2352 by 1568 pixels. Color fundus photograph — 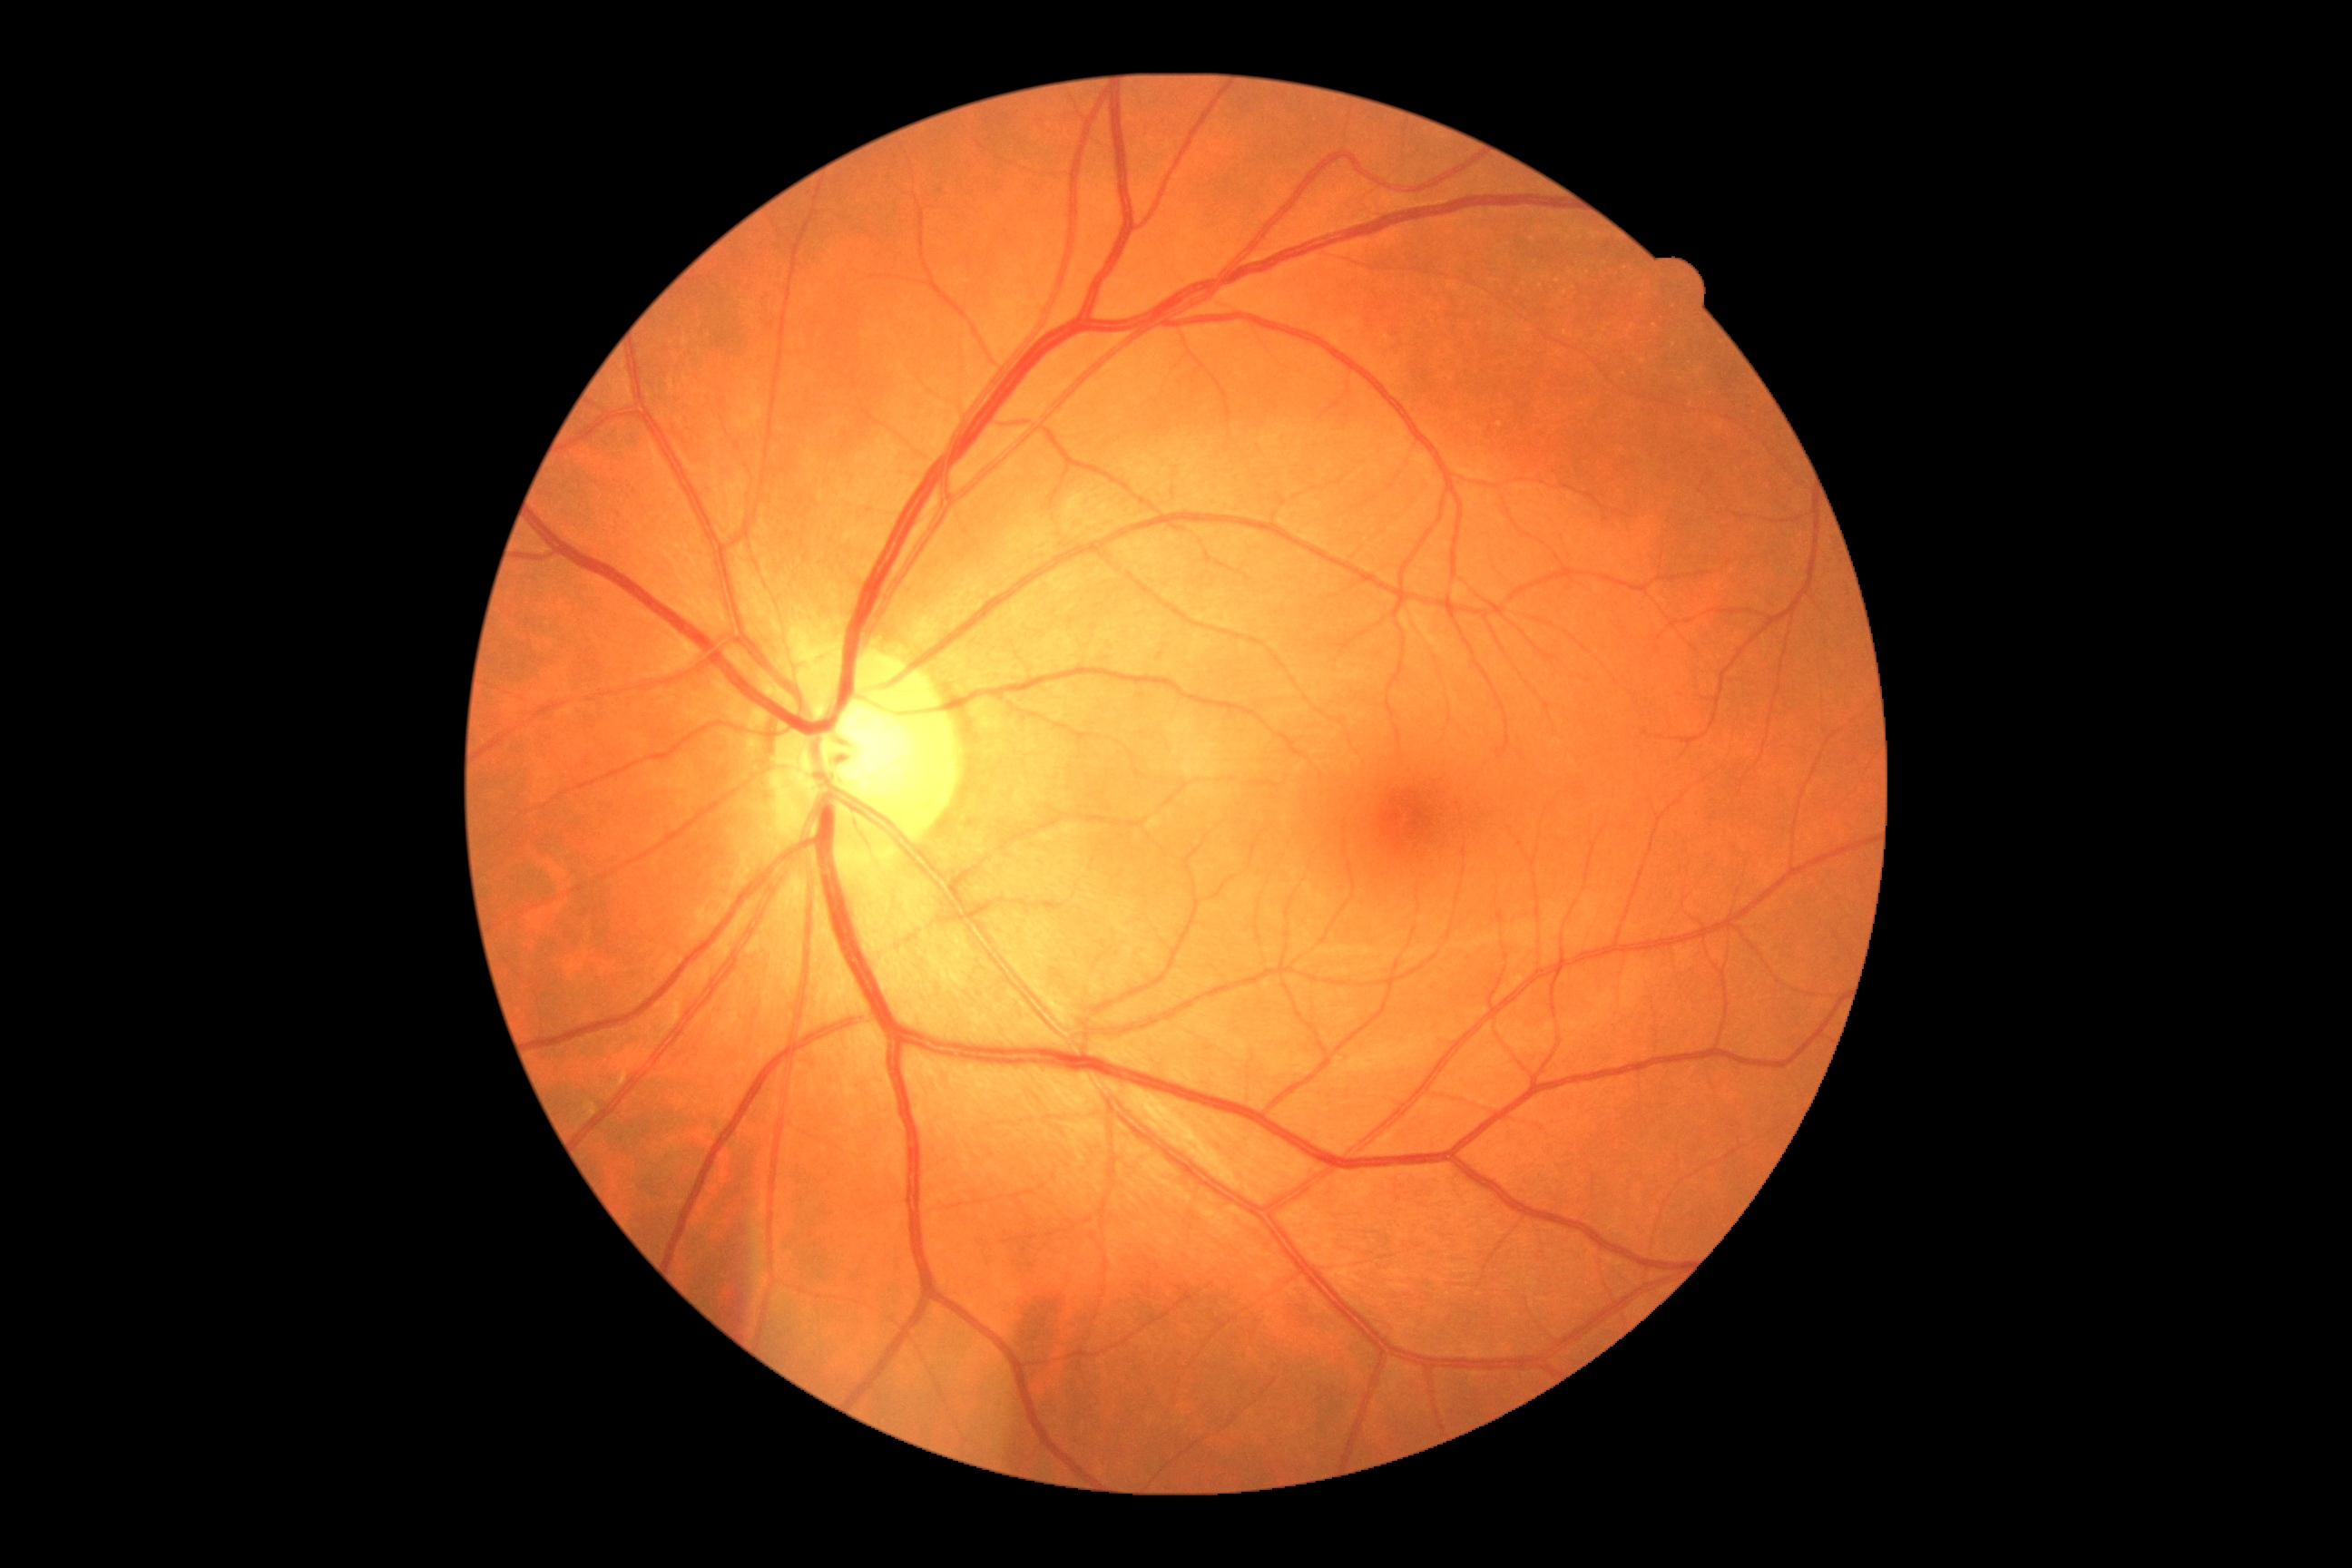 Diabetic retinopathy: grade 0 (no apparent retinopathy).